Without pupil dilation. Image size 848x848. Camera: NIDEK AFC-230. 45-degree field of view. Posterior pole color fundus photograph
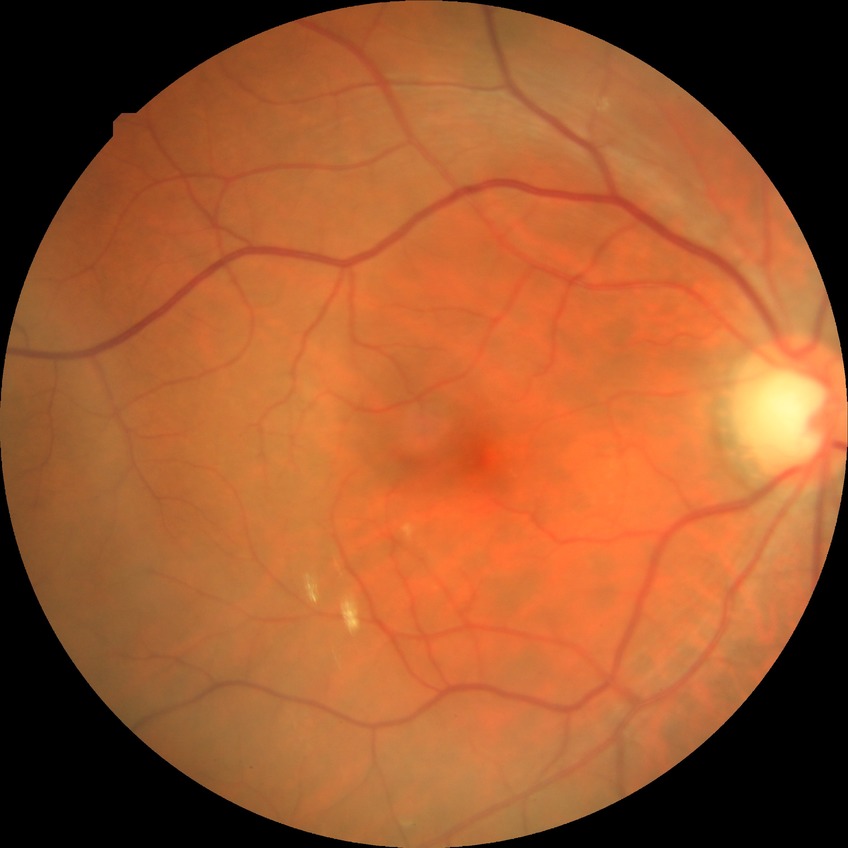
DR impression: negative for DR; DR grade: NDR.